Fundus photo. 45-degree field of view. 2048x1536px
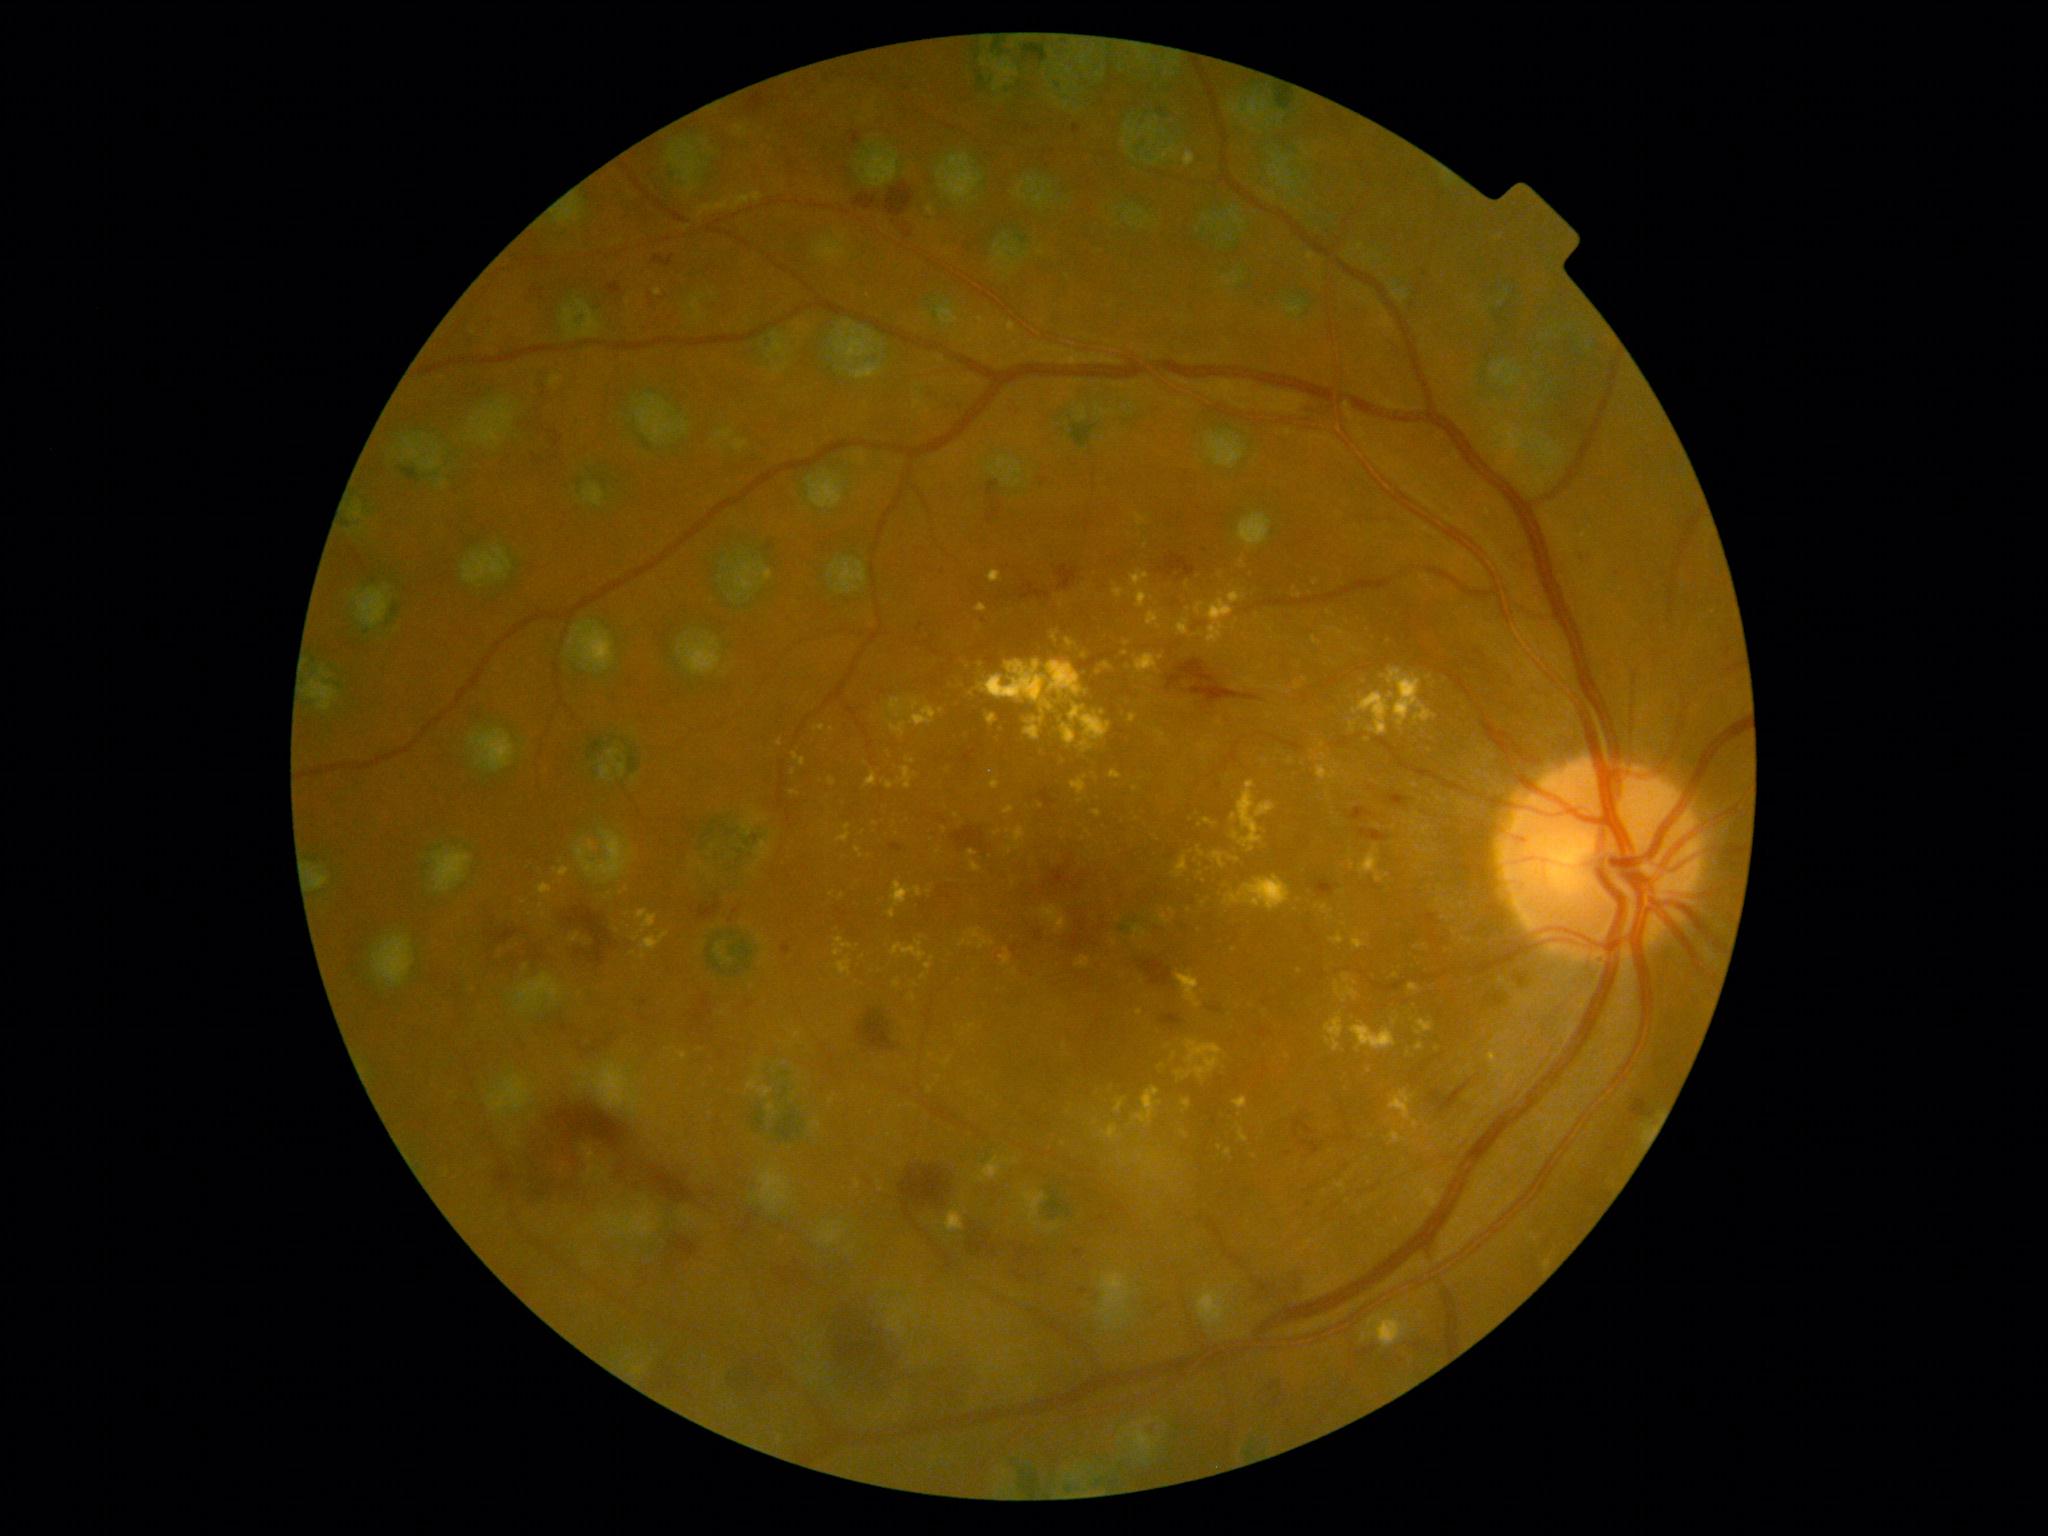
DR grade: 3 — more than 20 intraretinal hemorrhages in each of 4 quadrants, definite venous beading in 2 or more quadrants, or prominent intraretinal microvascular abnormalities in 1 or more quadrants, with no signs of proliferative retinopathy.